Acquired with a Remidio Fundus on Phone; retinal fundus photograph — 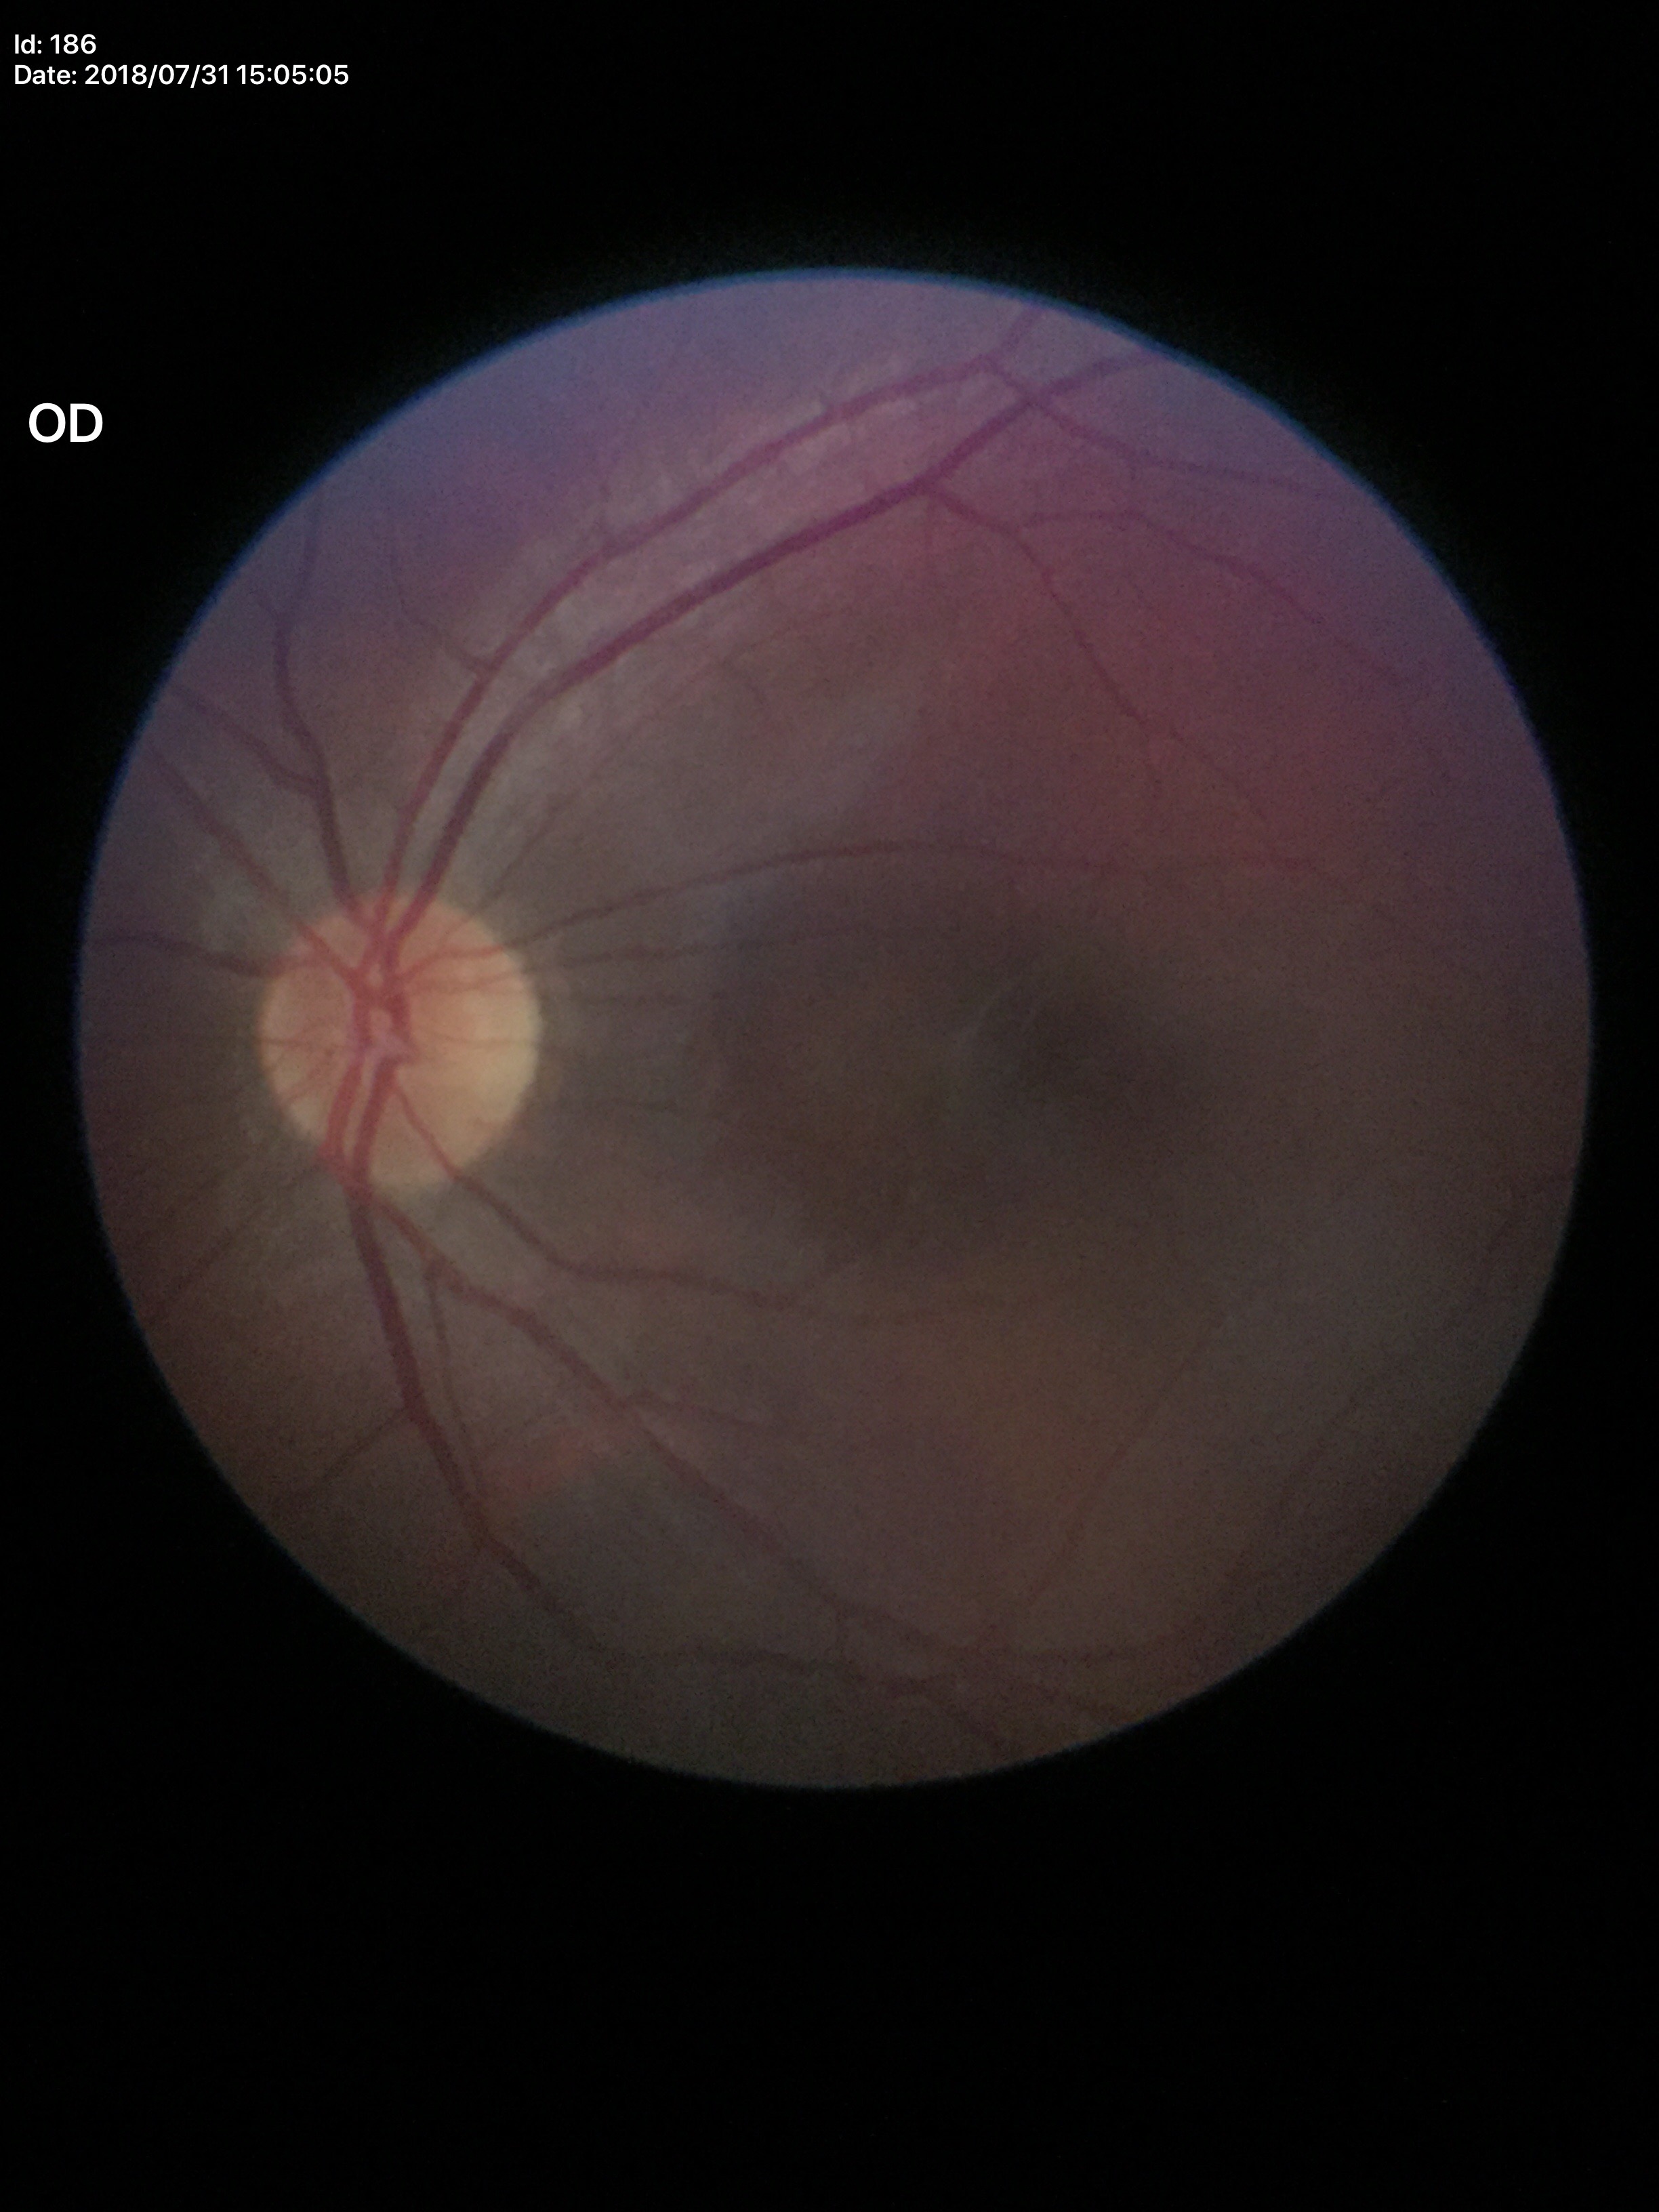

Findings:
– Glaucoma screening · no suspicious findings (5/5 ophthalmologists in agreement)
– vertical CDR (VCDR) · 0.44
– horizontal cup-disc ratio (HCDR) · 0.41
– area cup-disc ratio (ACDR) · 0.18